2212x1661px · axial length (AL) 22.73 mm · acquired with a Topcon TRC-NW400 · gender: M: 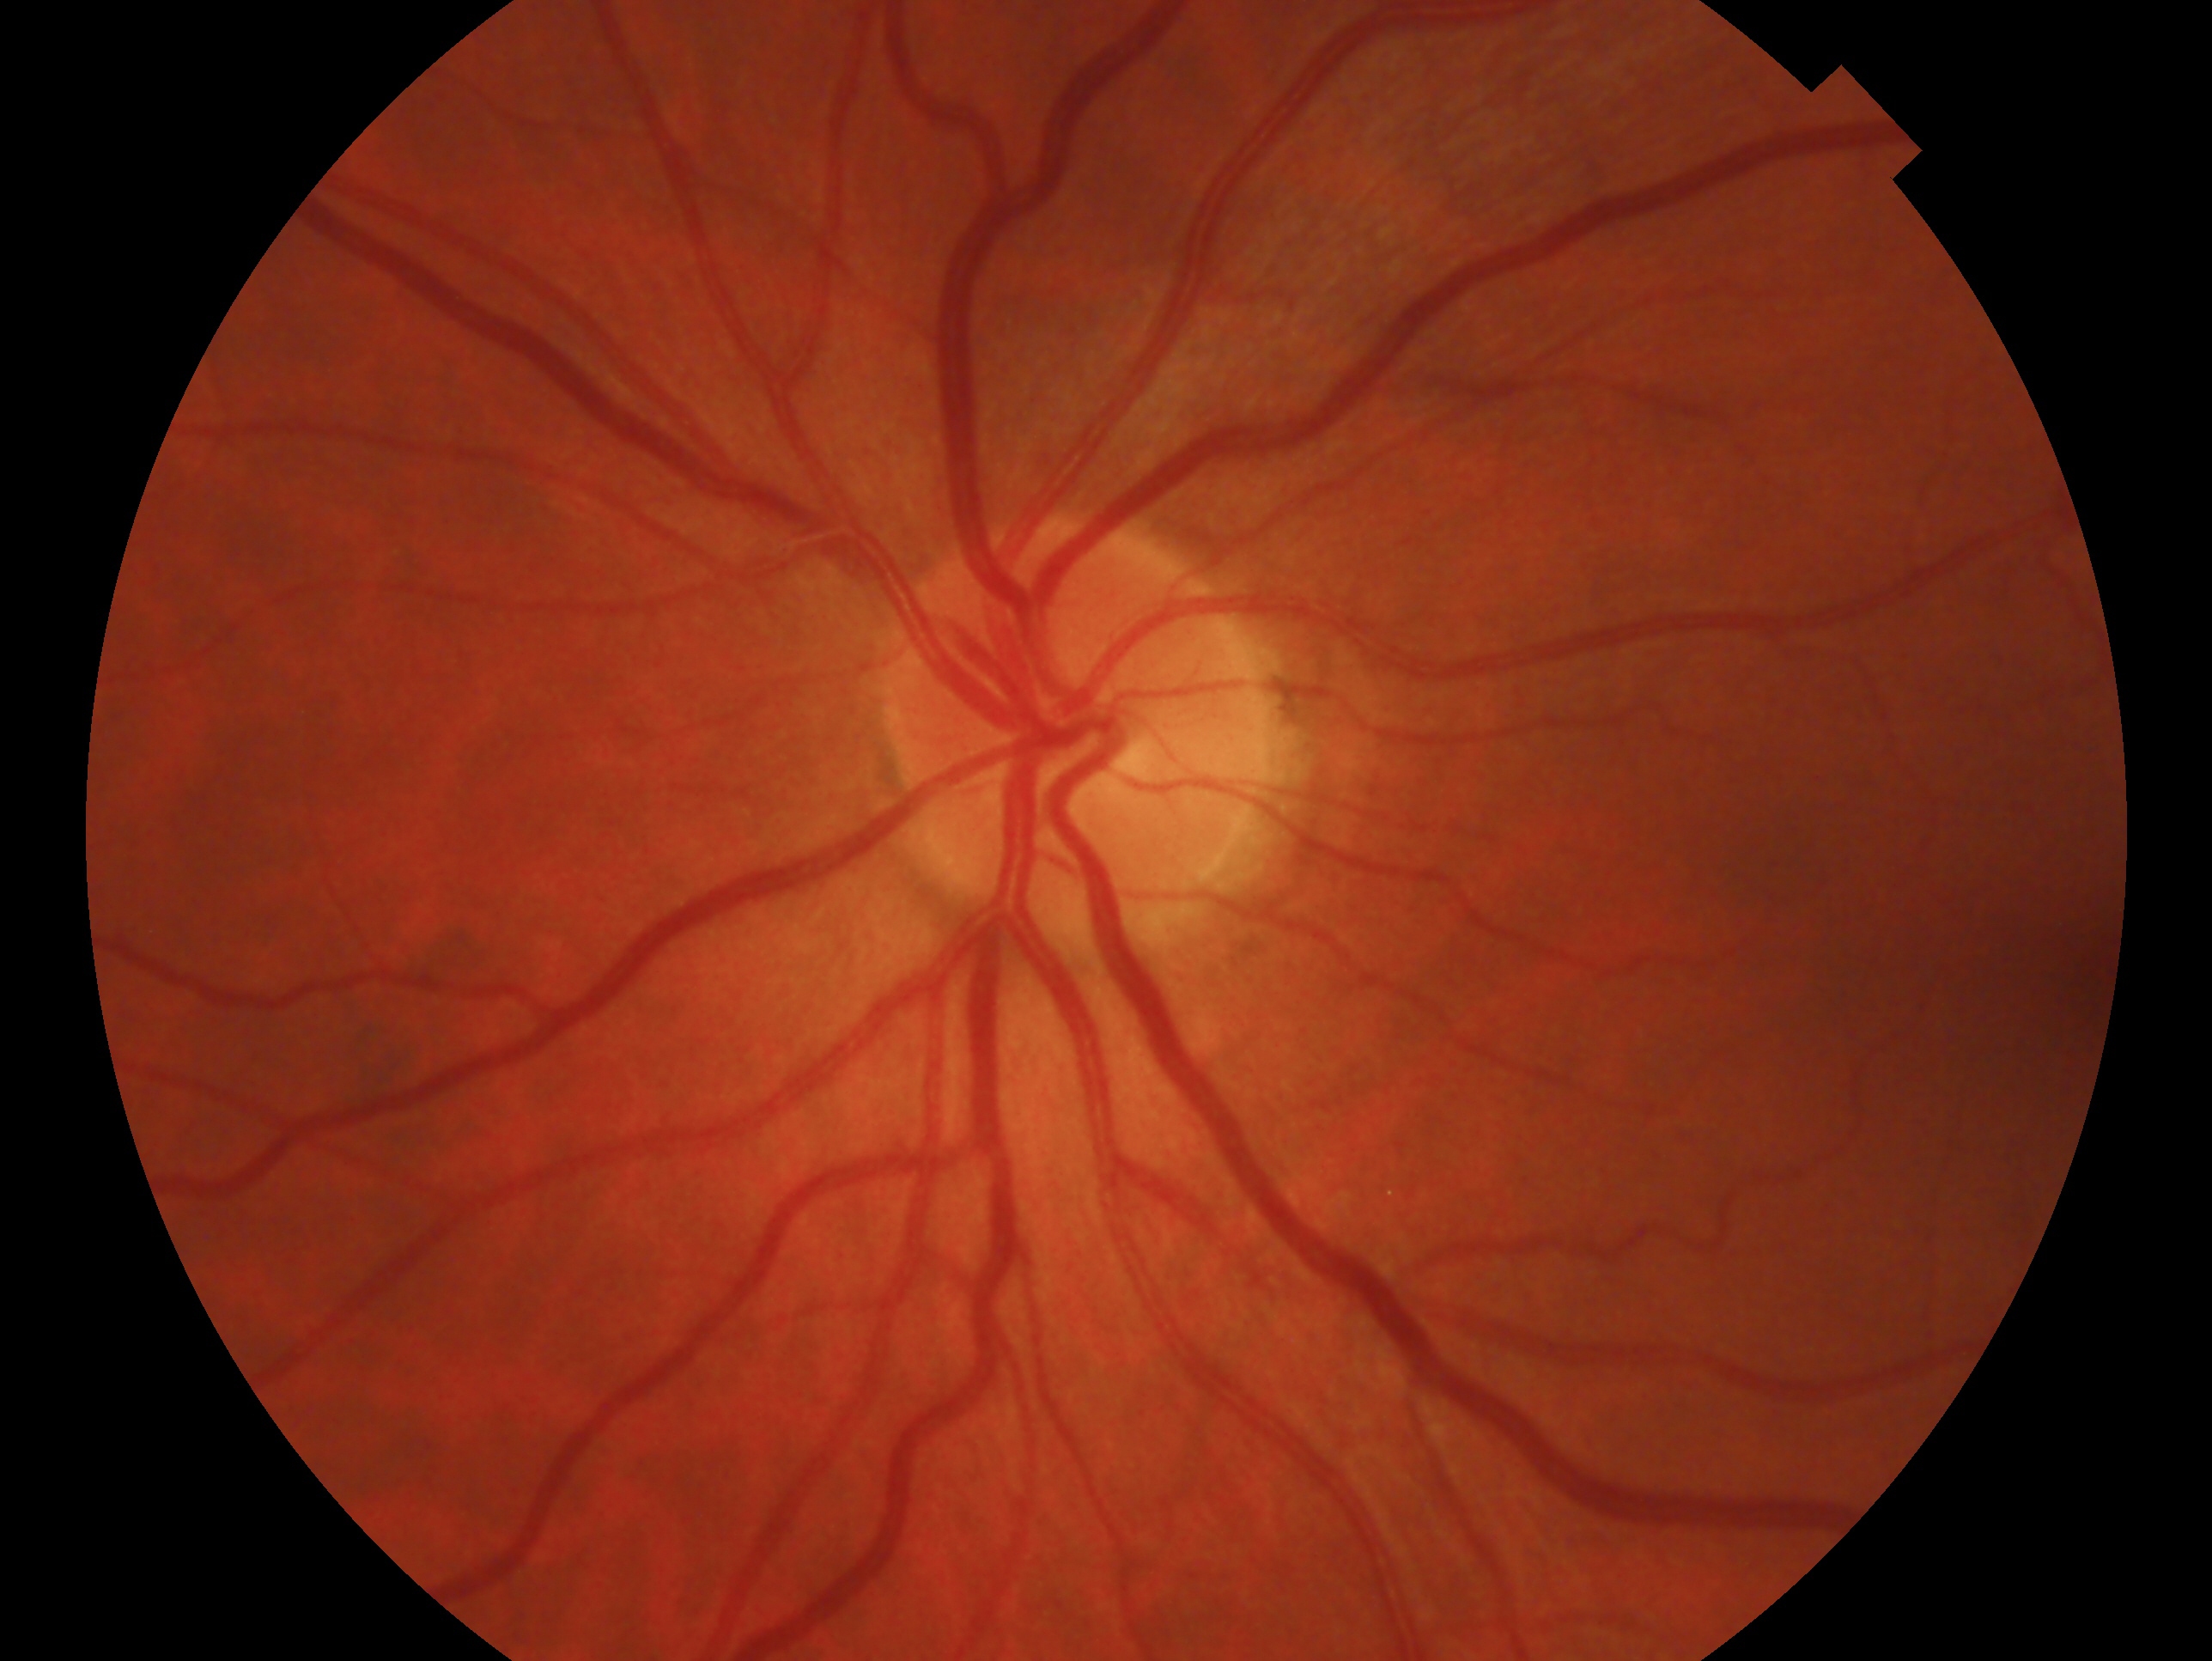 This is the OS. Clinical classification — no signs of glaucoma.